FOV: 45 degrees
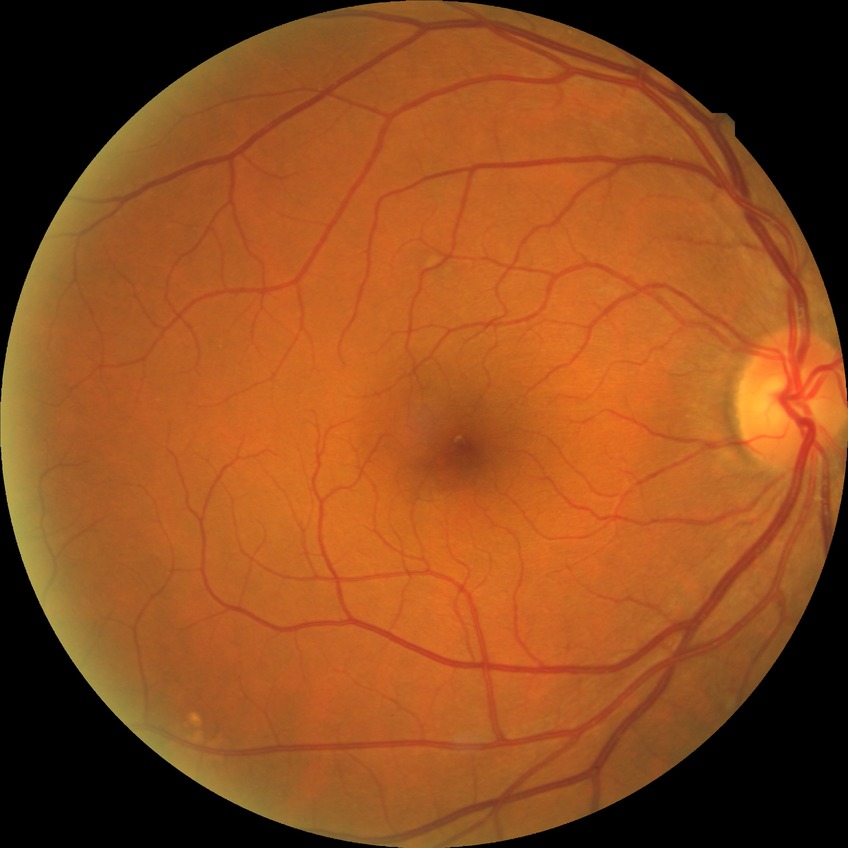 DR severity: SDR.